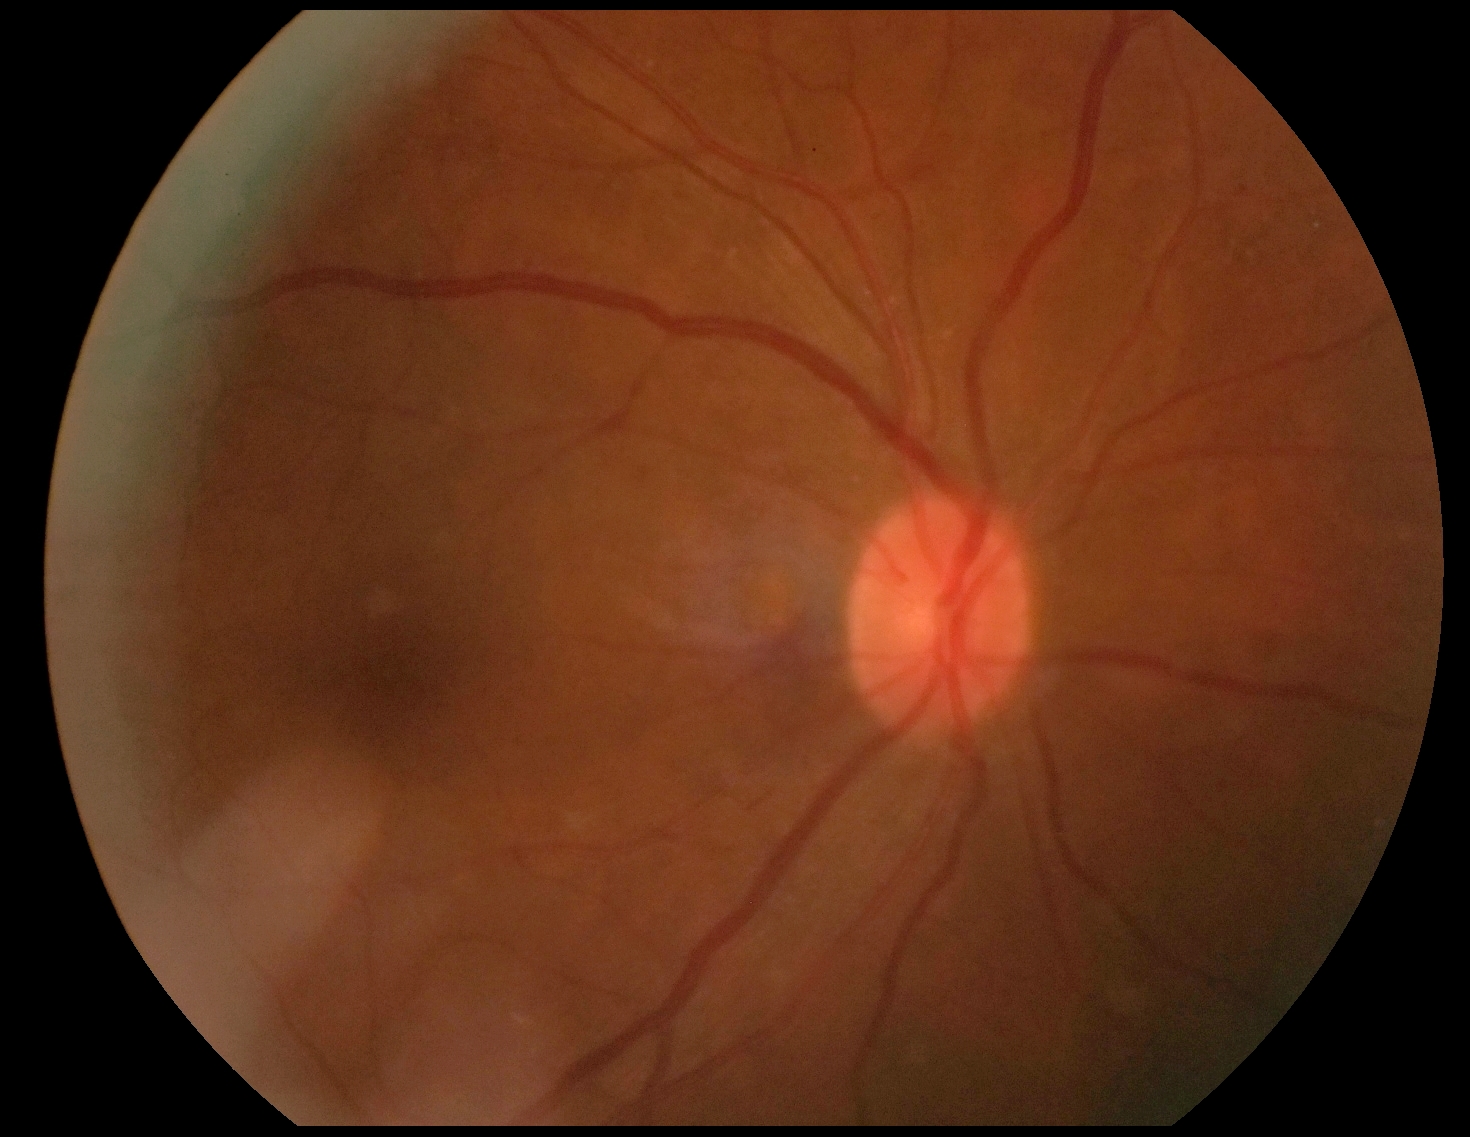 retinopathy: 2.